Pediatric retinal photograph (wide-field): 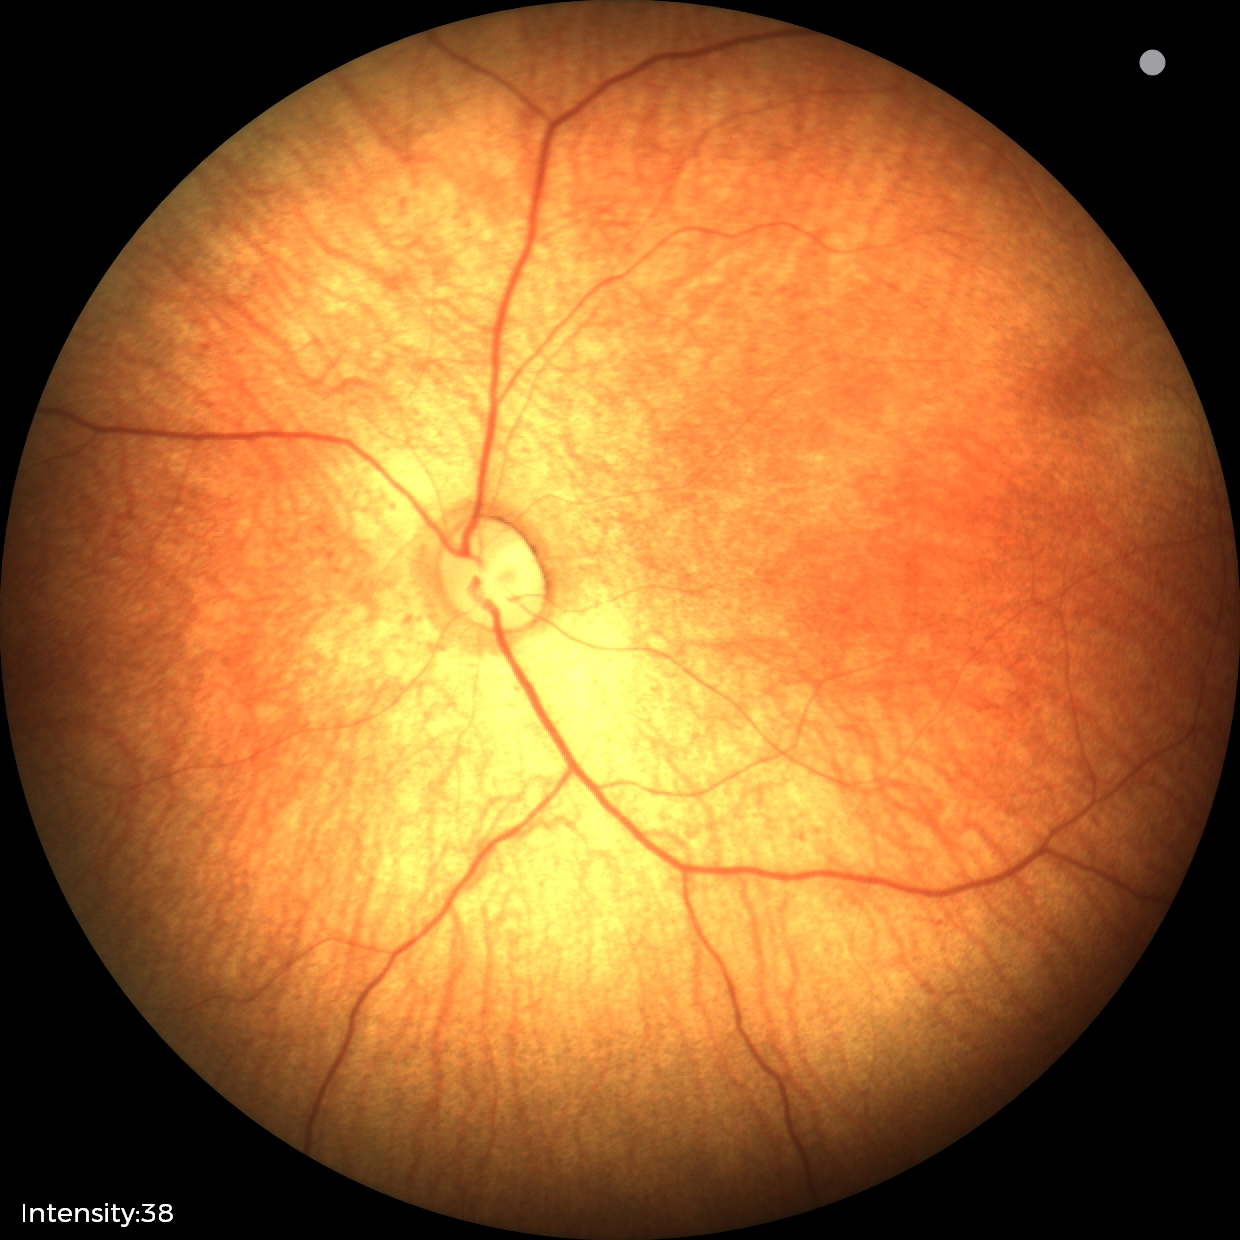
Physiological retinal appearance for postconceptual age.